Optic disc-centered. FOV: 30 degrees. Pachymetry: 600 µm. Visual field mean defect (MD): -2.33 dB. Captured without pupil dilation. Intraocular pressure (IOP) by applanation tonometry: 18 mmHg. Acquired with a Topcon TRC-NW400.
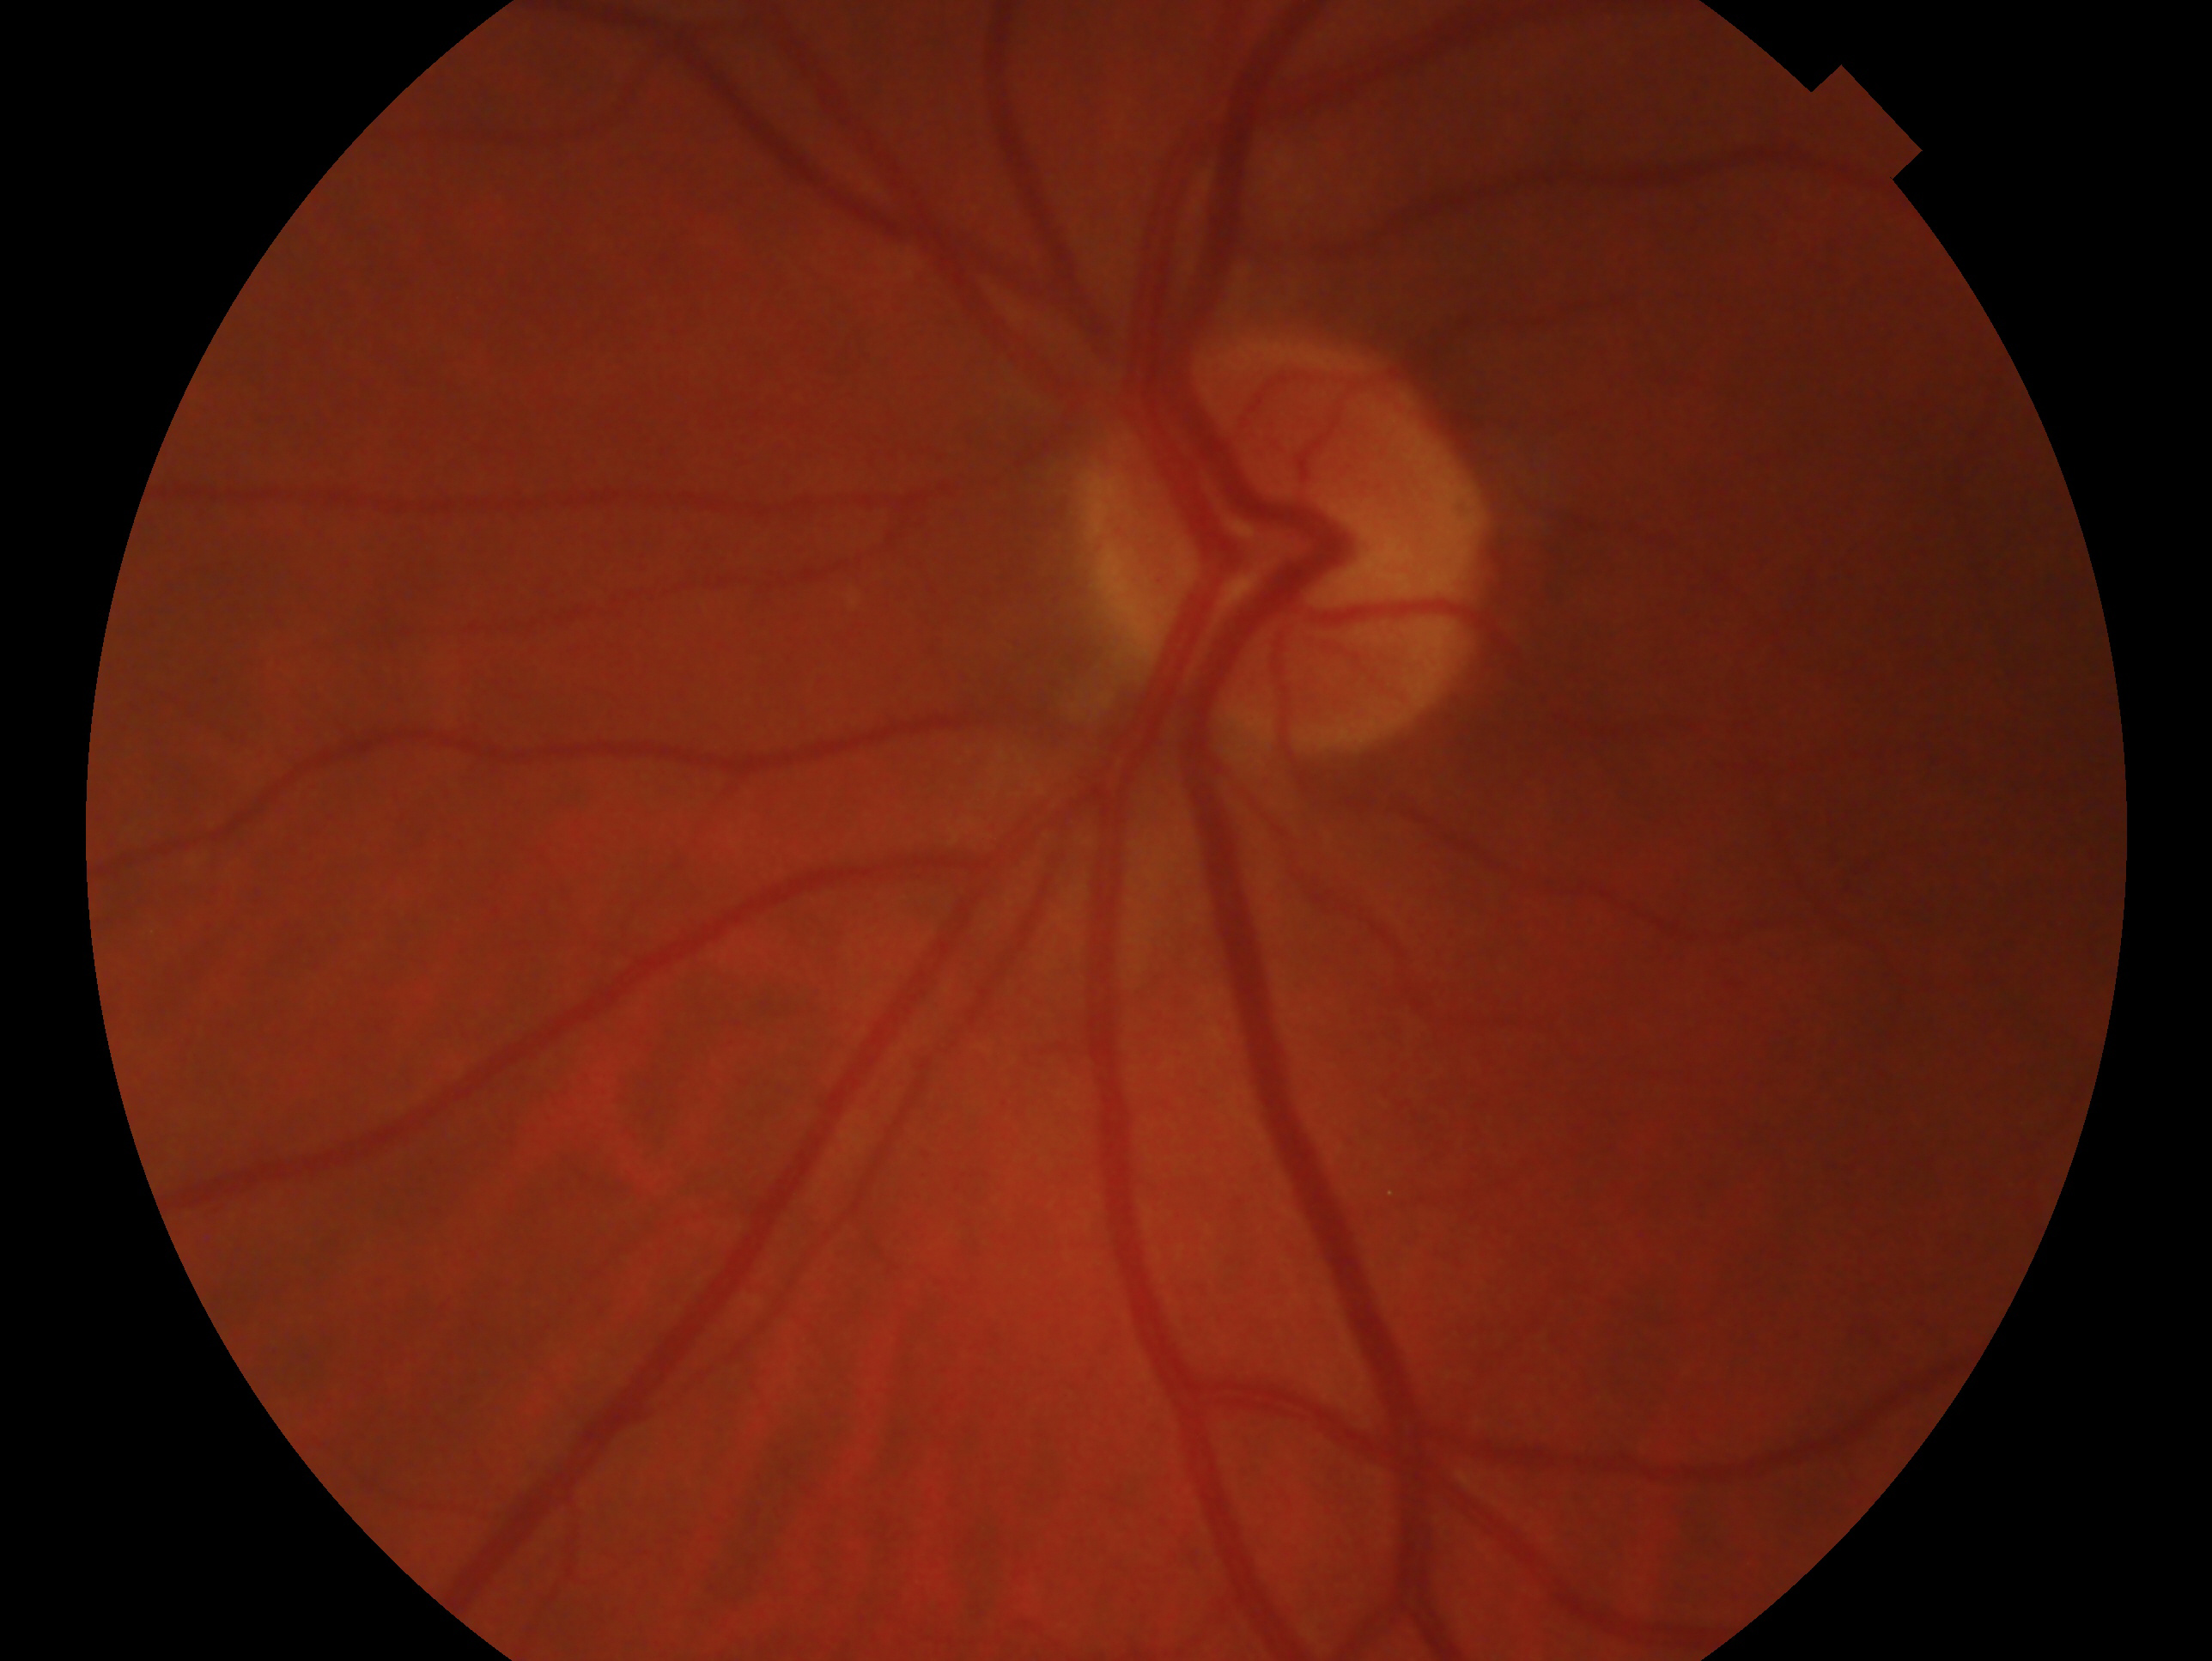

Glaucoma assessment: glaucoma.
Imaged eye: left.